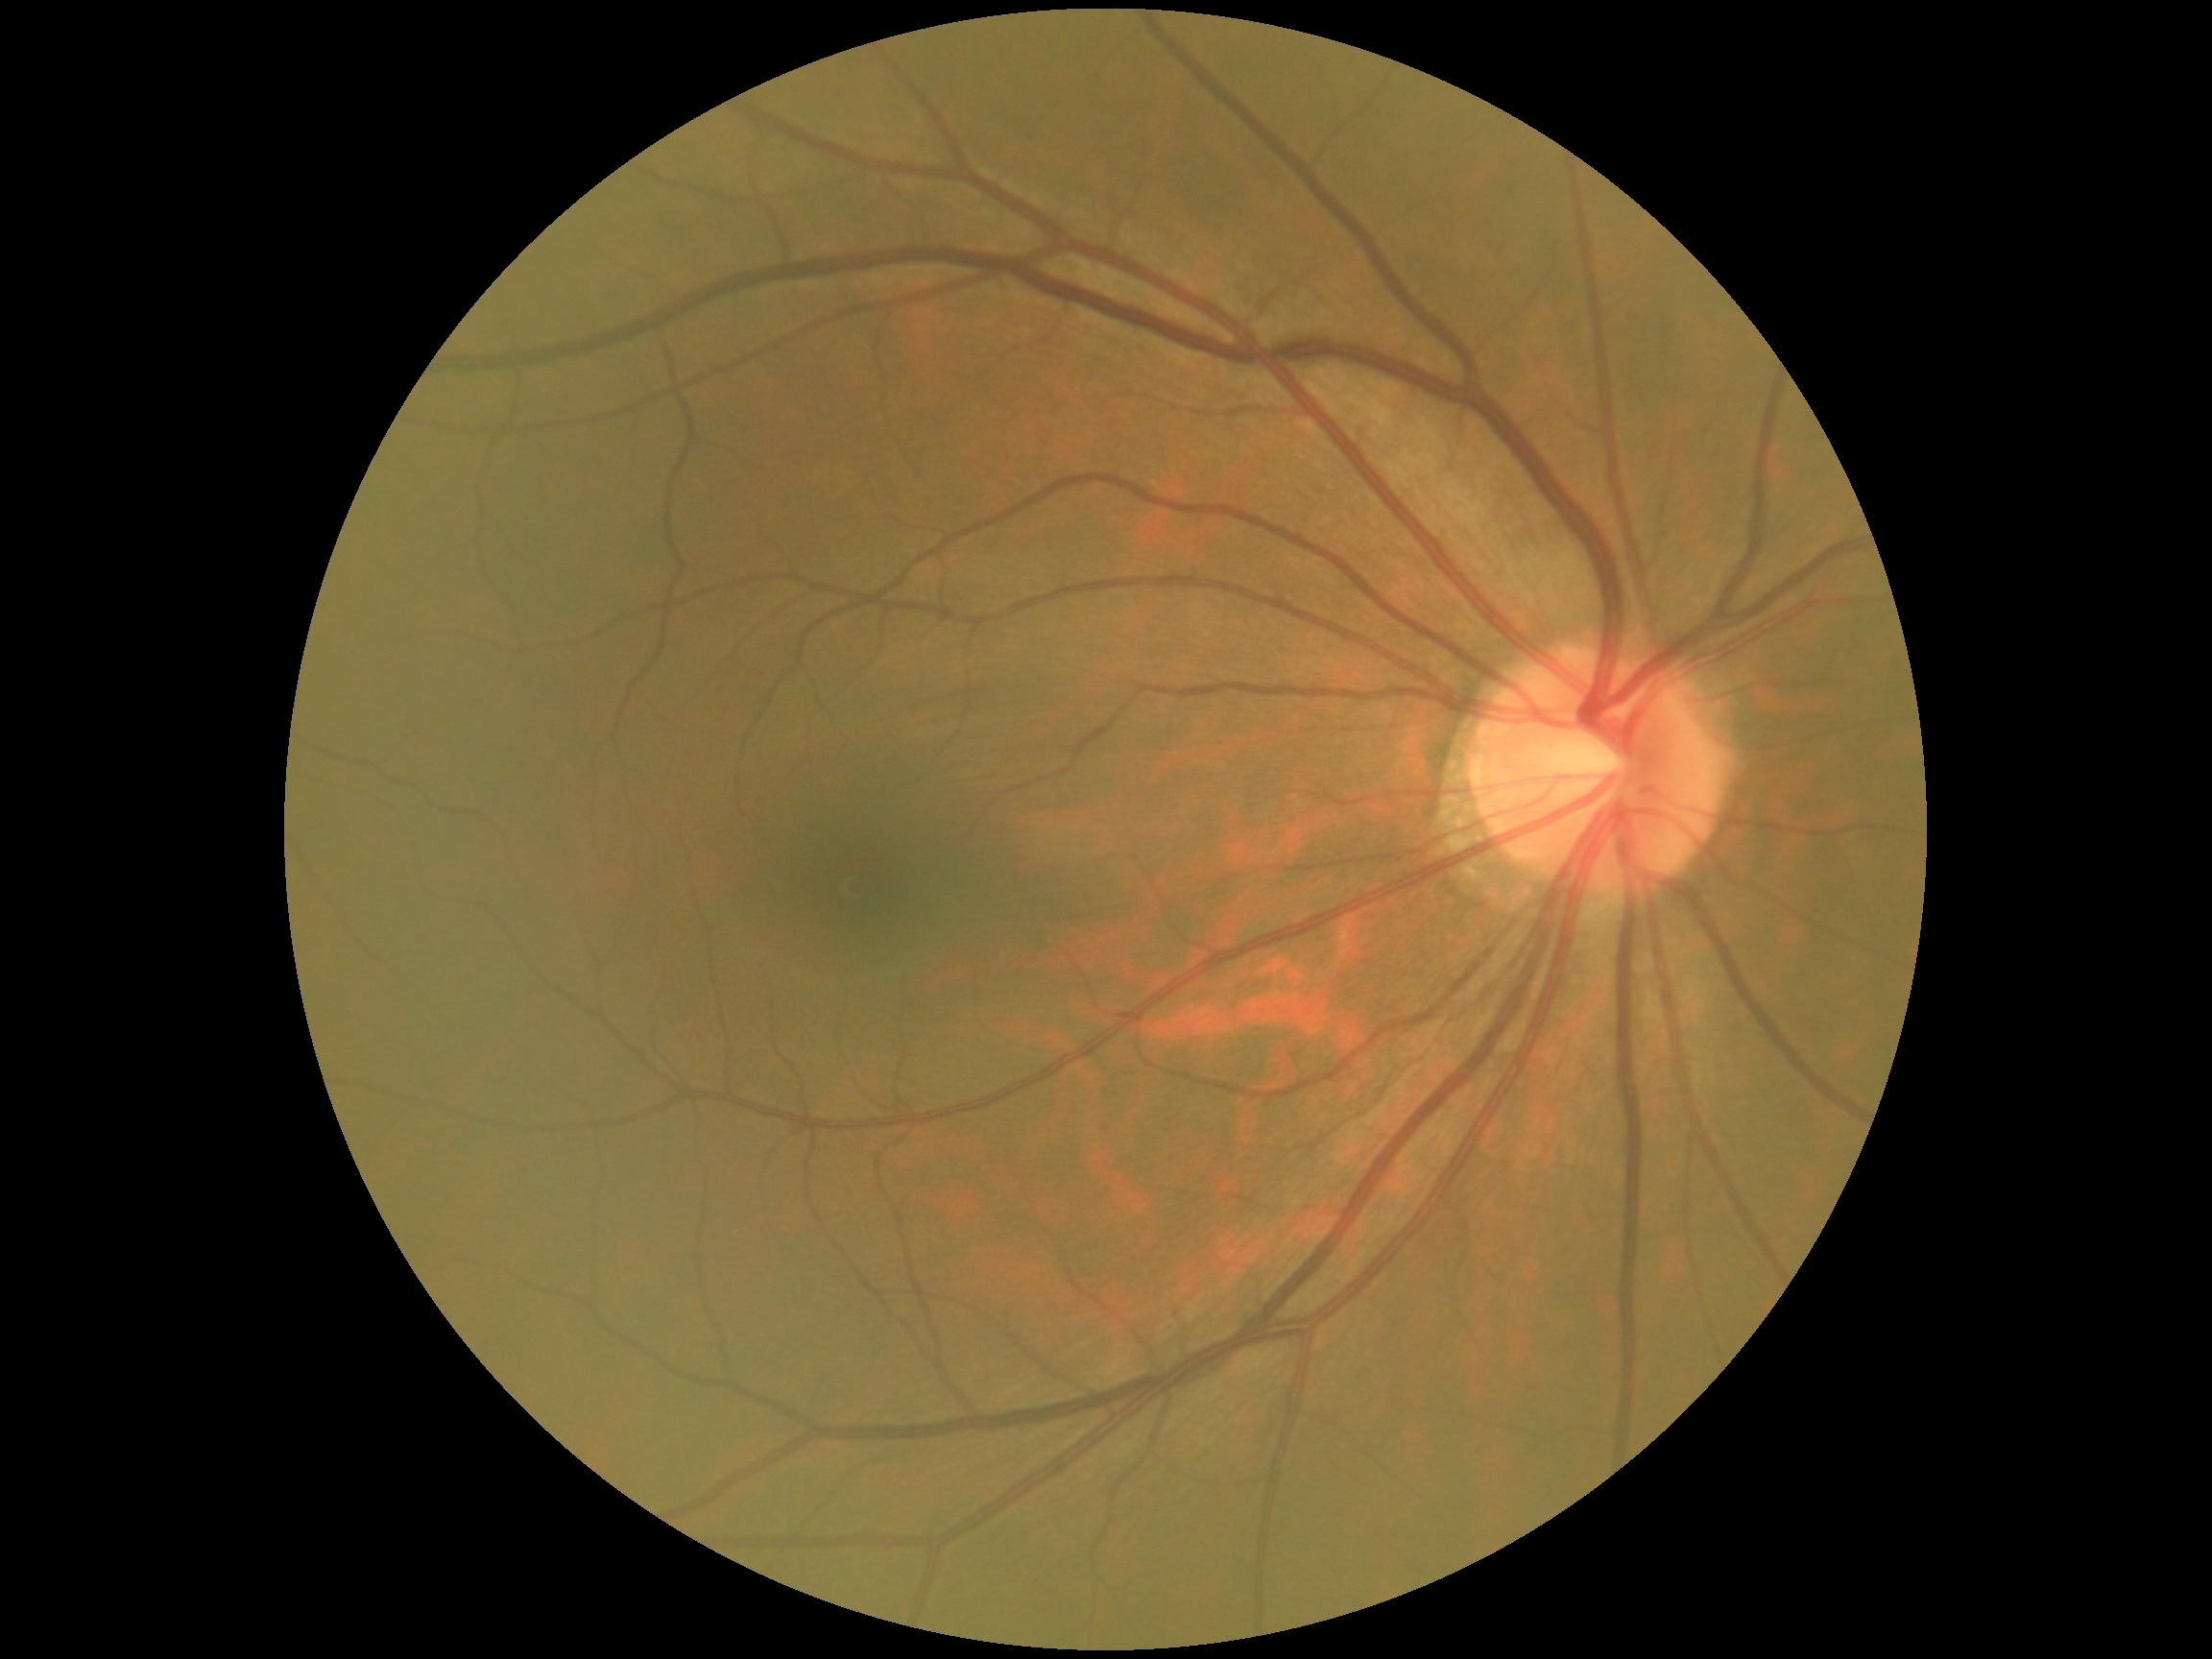
DR grade is 0/4.